Posterior pole photograph — 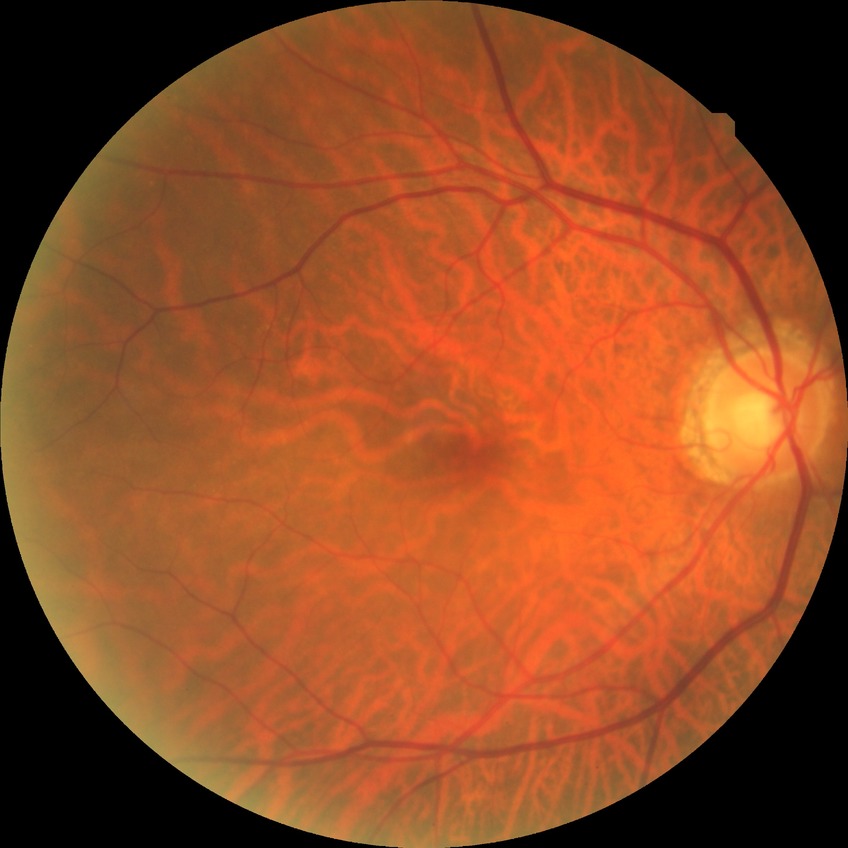

Diabetic retinopathy (DR) is no diabetic retinopathy (NDR).